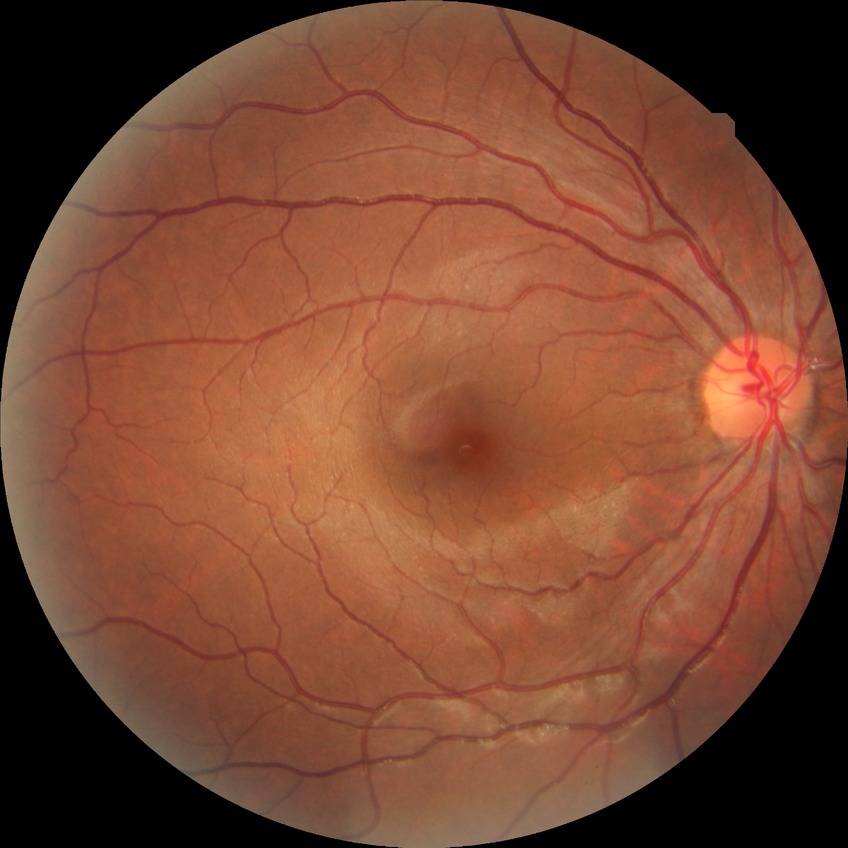
davis_grade: NDR (no diabetic retinopathy)